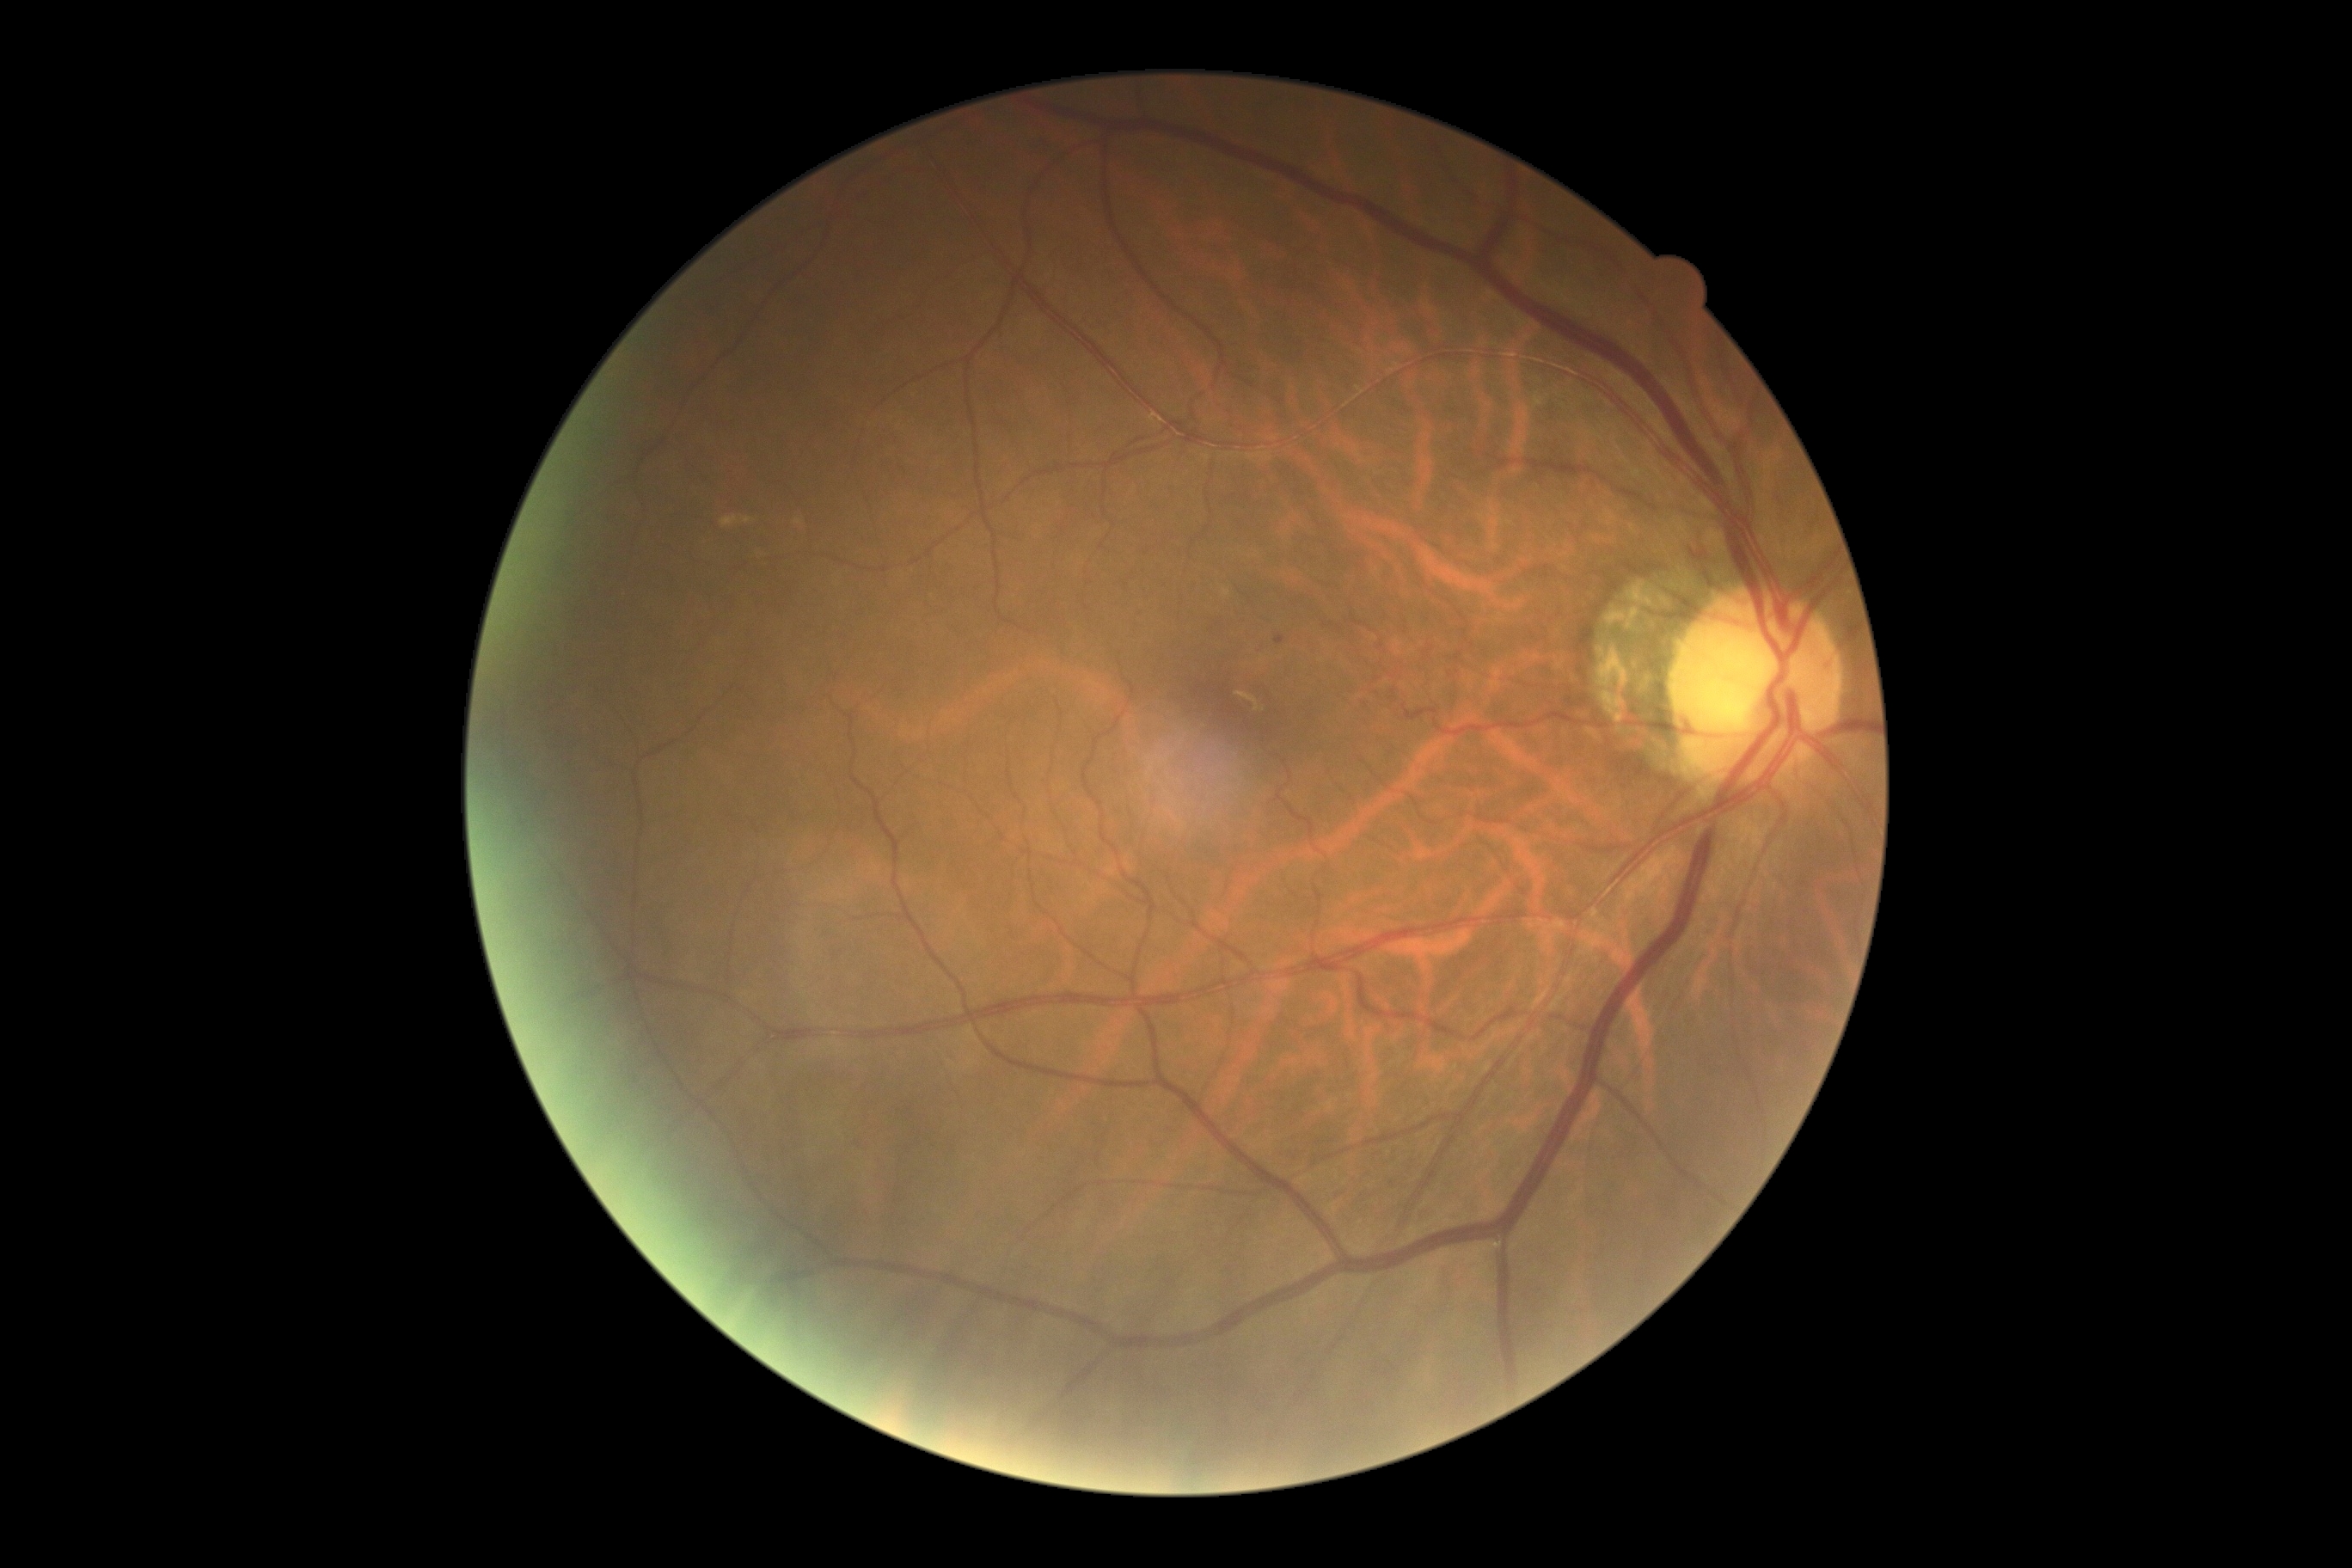

{"dr_grade": "grade 1"}